Patient age: 43 years — 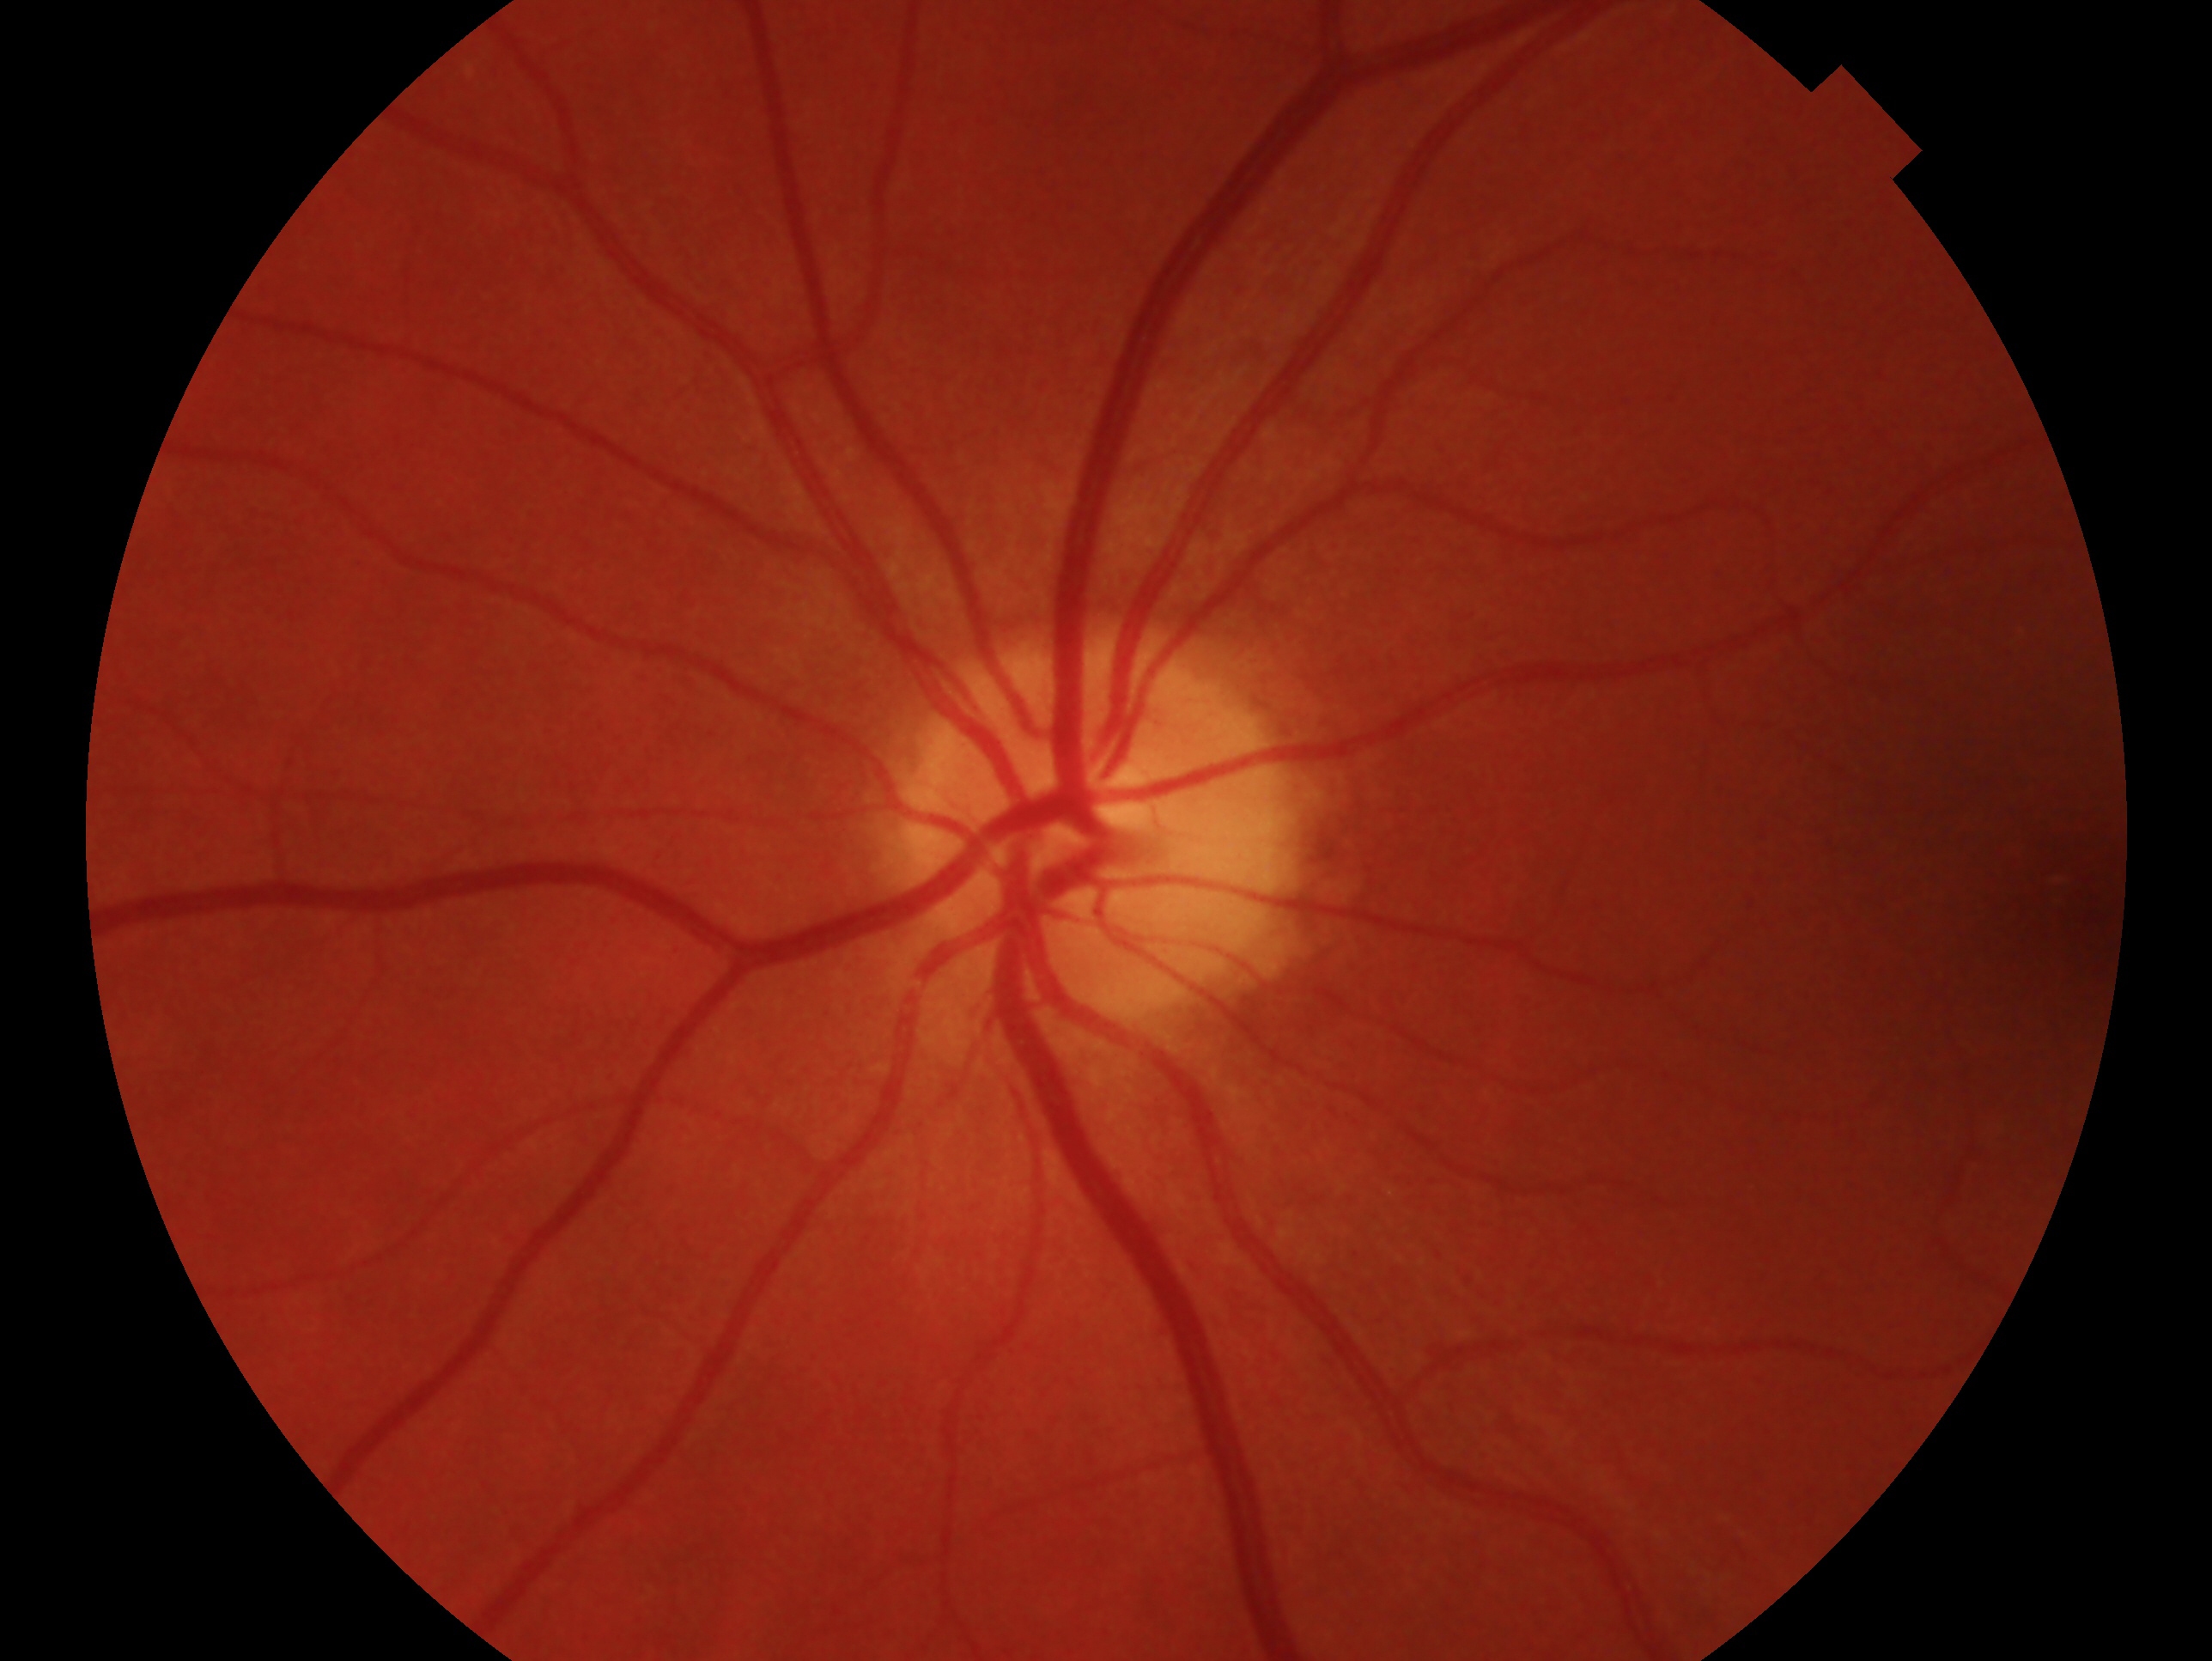
impression: negative for glaucoma
laterality: left eye